NIDEK AFC-230 fundus camera; 45 degree fundus photograph; nonmydriatic.
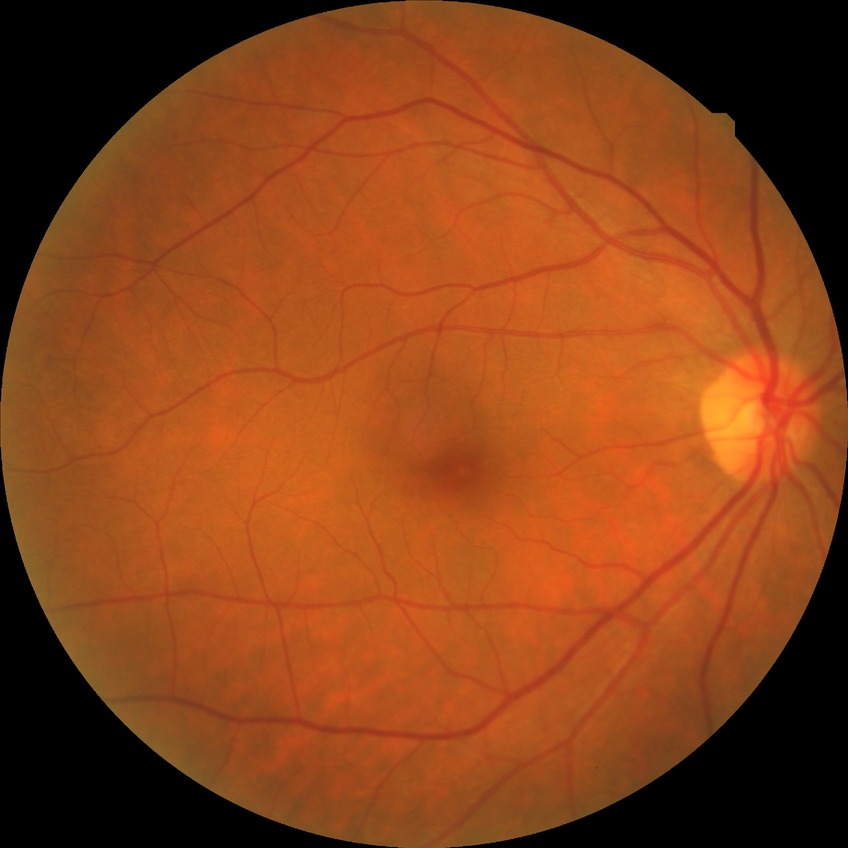
diabetic retinopathy (DR)=NDR (no diabetic retinopathy).